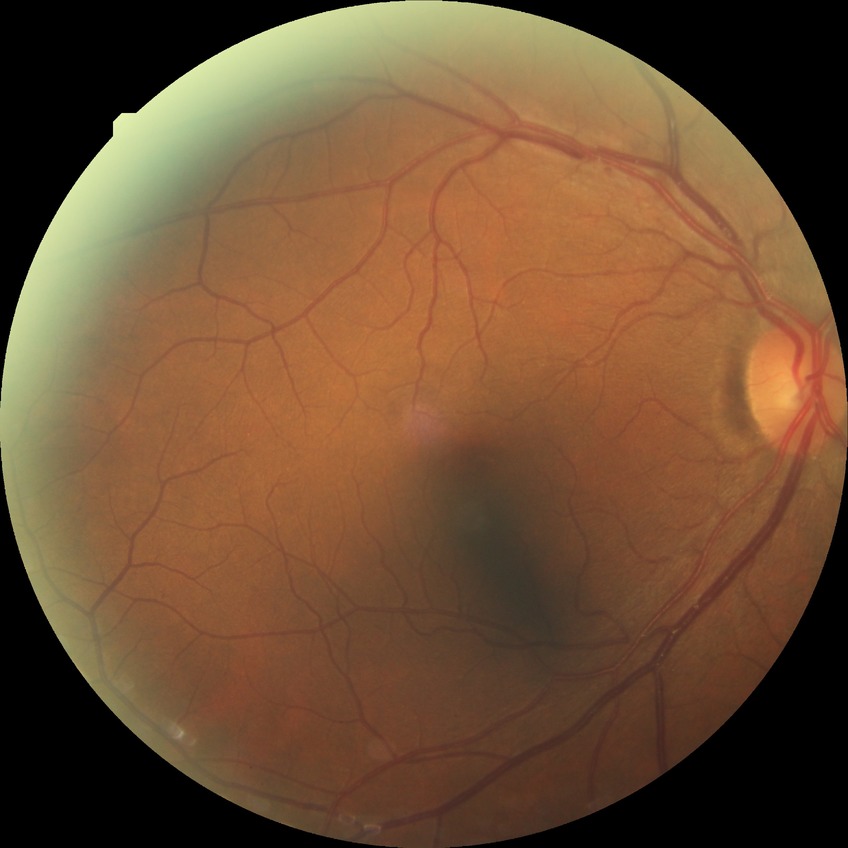

diabetic retinopathy (DR)@NDR (no diabetic retinopathy).